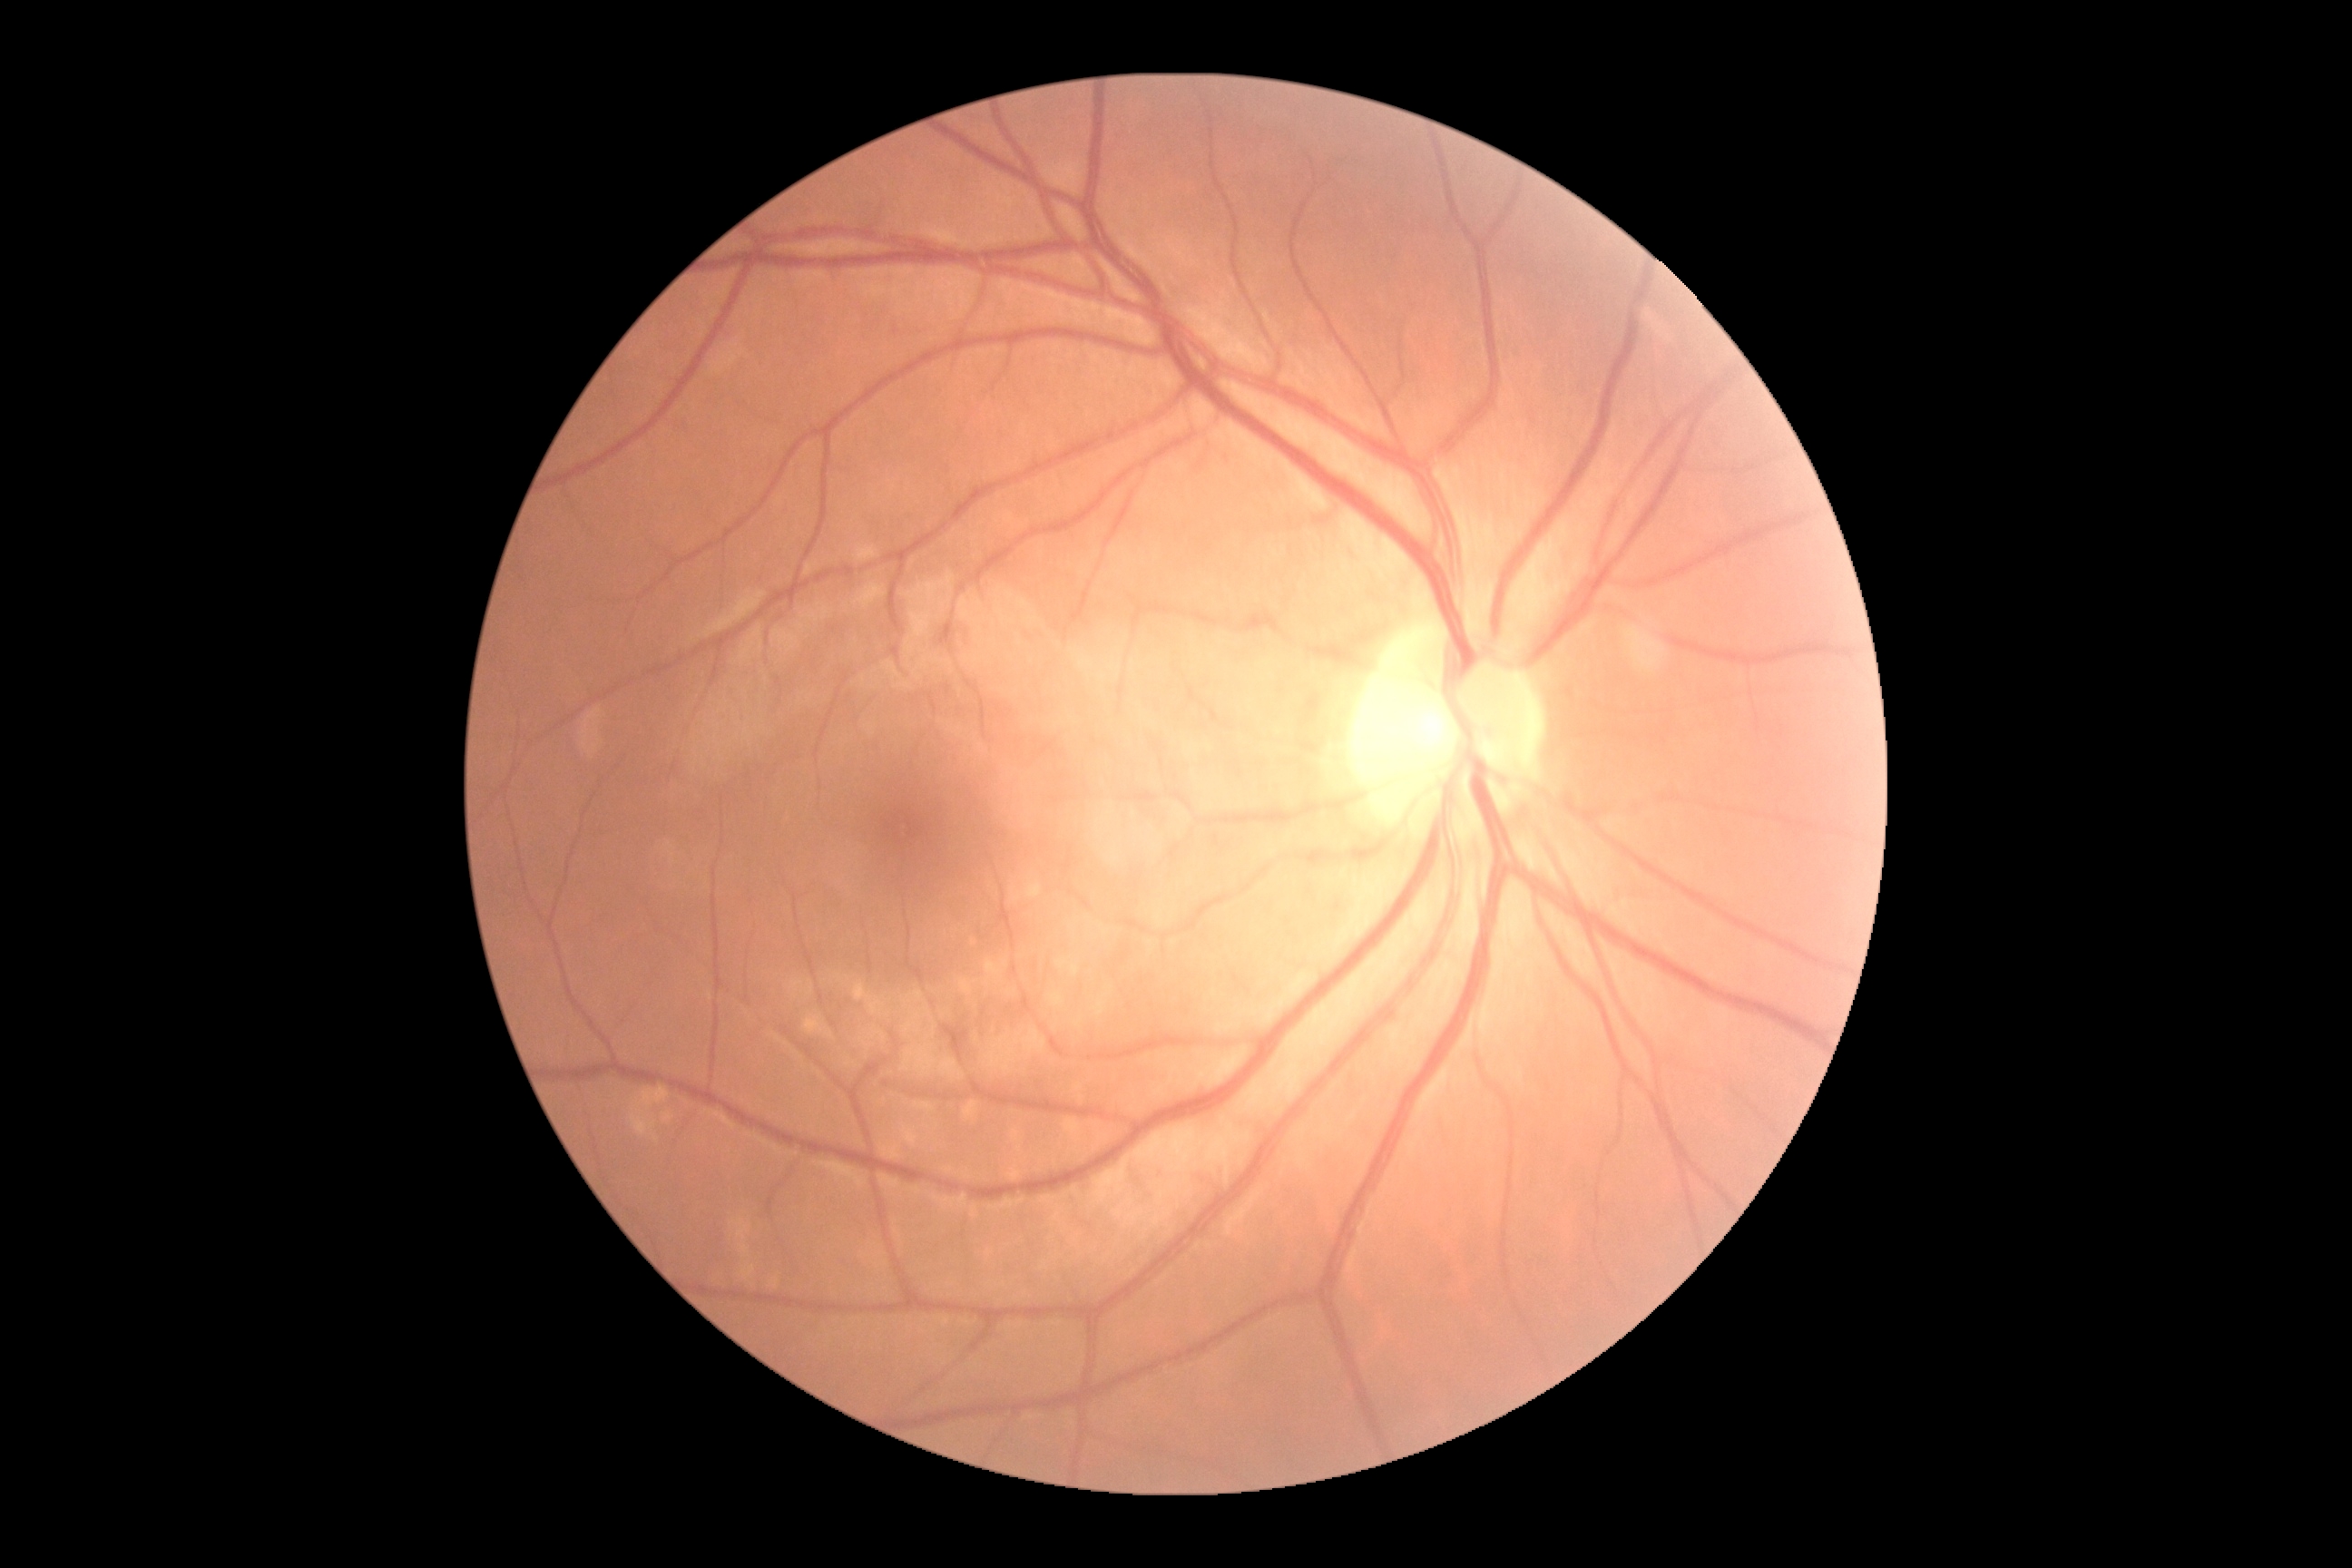

Diabetic retinopathy severity: no apparent diabetic retinopathy (grade 0) — no visible signs of diabetic retinopathy.